Acquired on the Phoenix ICON; 1240x1240; infant wide-field fundus photograph:
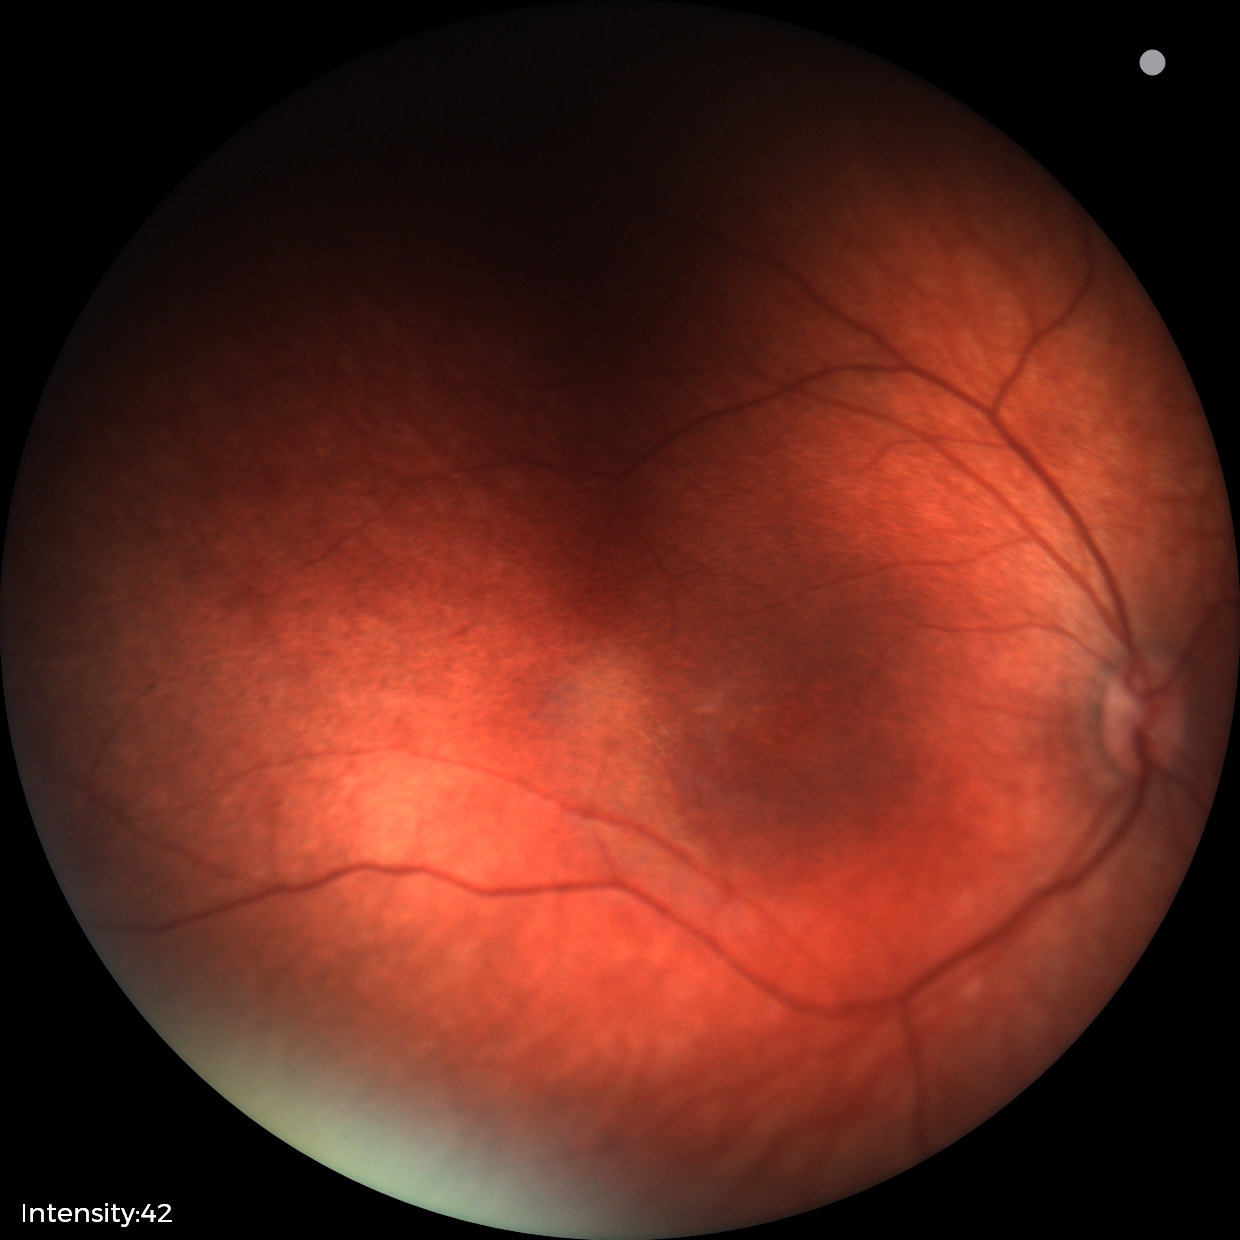

Assessment: physiological finding.